NIDEK AFC-230; FOV: 45 degrees:
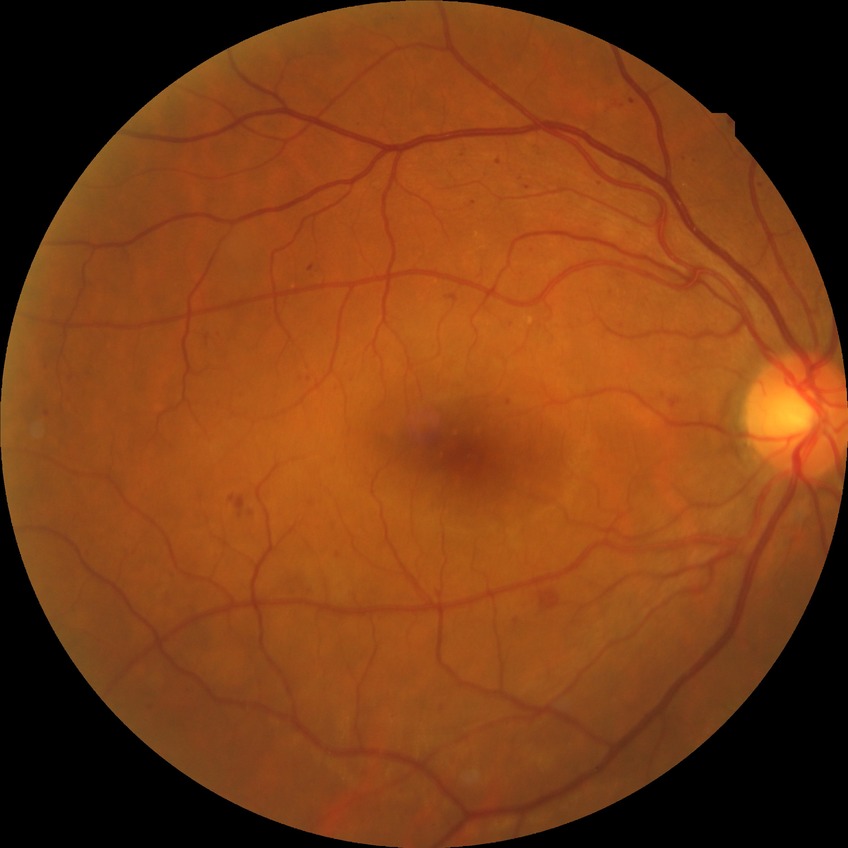

diabetic retinopathy grade: pre-proliferative diabetic retinopathy.